Image size 640x480. Clarity RetCam 3, 130° FOV. Infant wide-field fundus photograph — 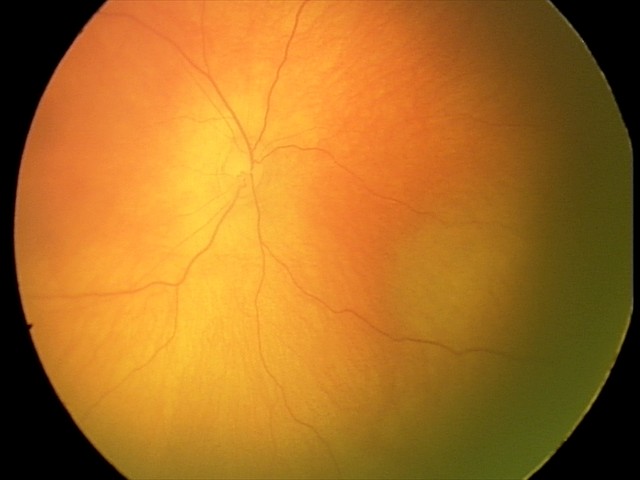 Impression: physiological retinal finding.